FOV: 45 degrees · modified Davis grading.
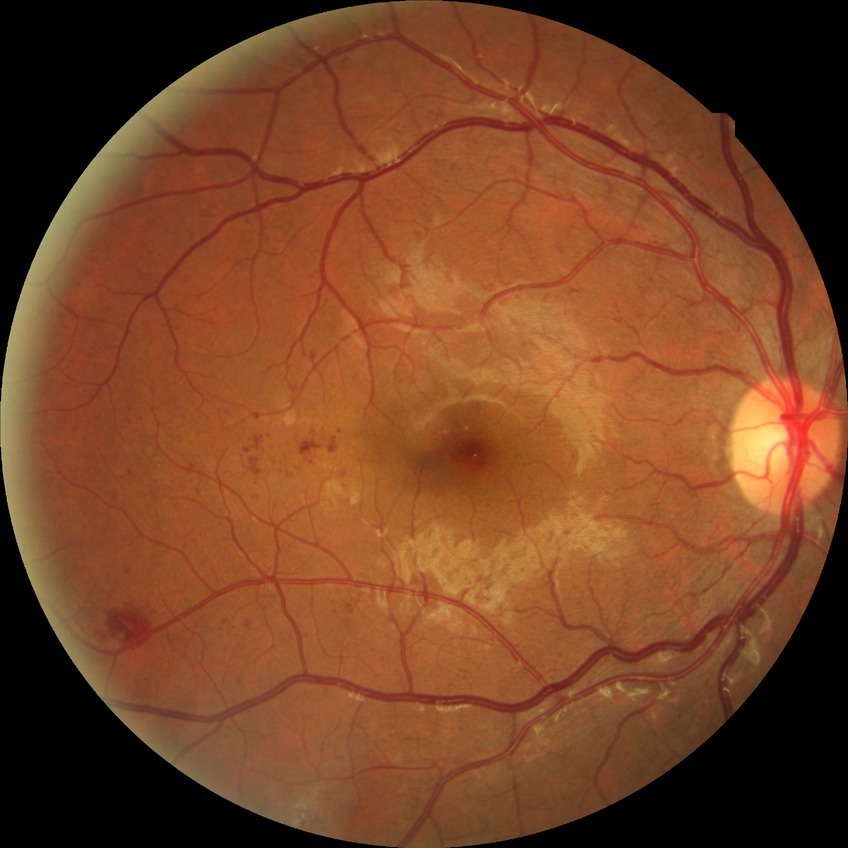
Davis stage: PPDR.